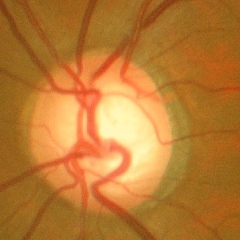 Diagnosis = early glaucoma.